2352x1568. CFP. 45° FOV
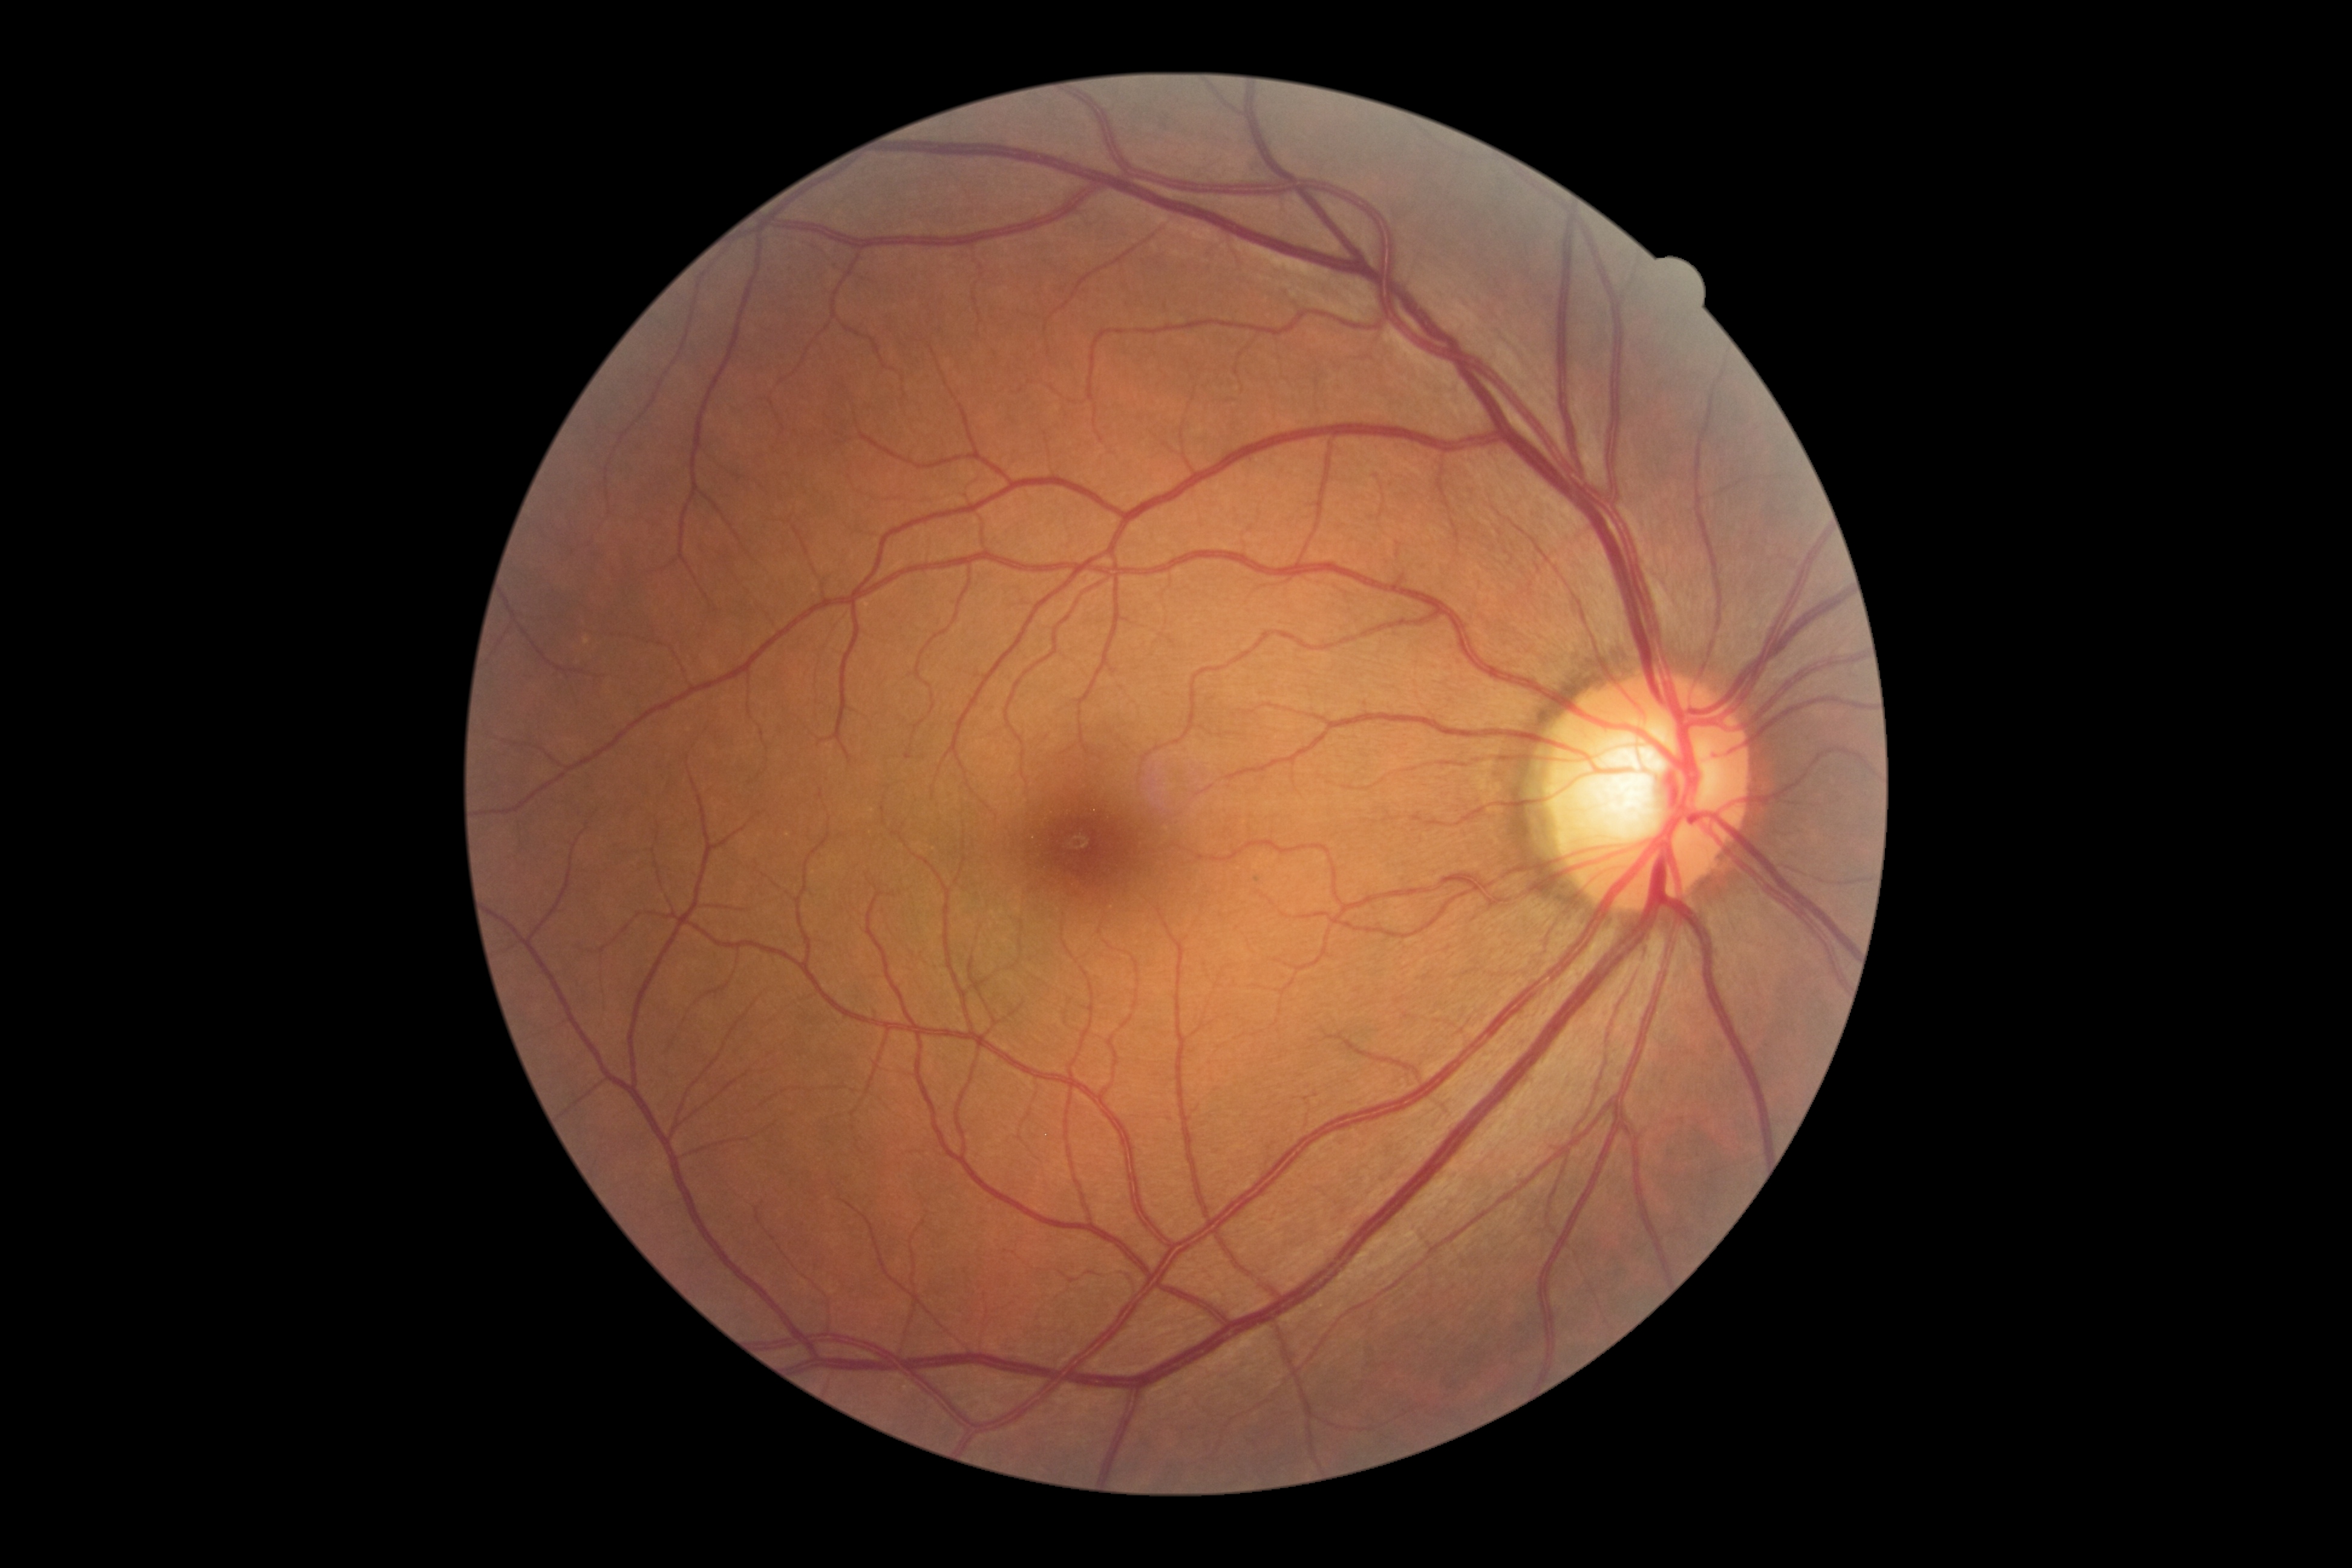
Retinopathy: grade 0 — no visible signs of diabetic retinopathy.